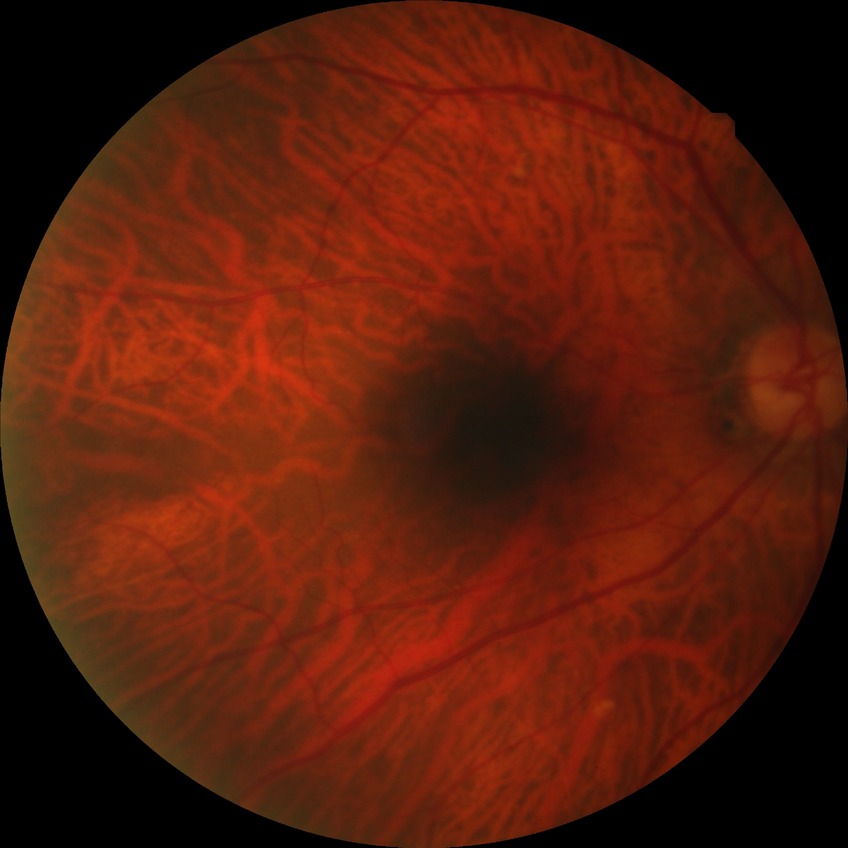 Diabetic retinopathy (DR) is no diabetic retinopathy (NDR).